Mydriatic (tropicamide phenylephrine 1.0%) — 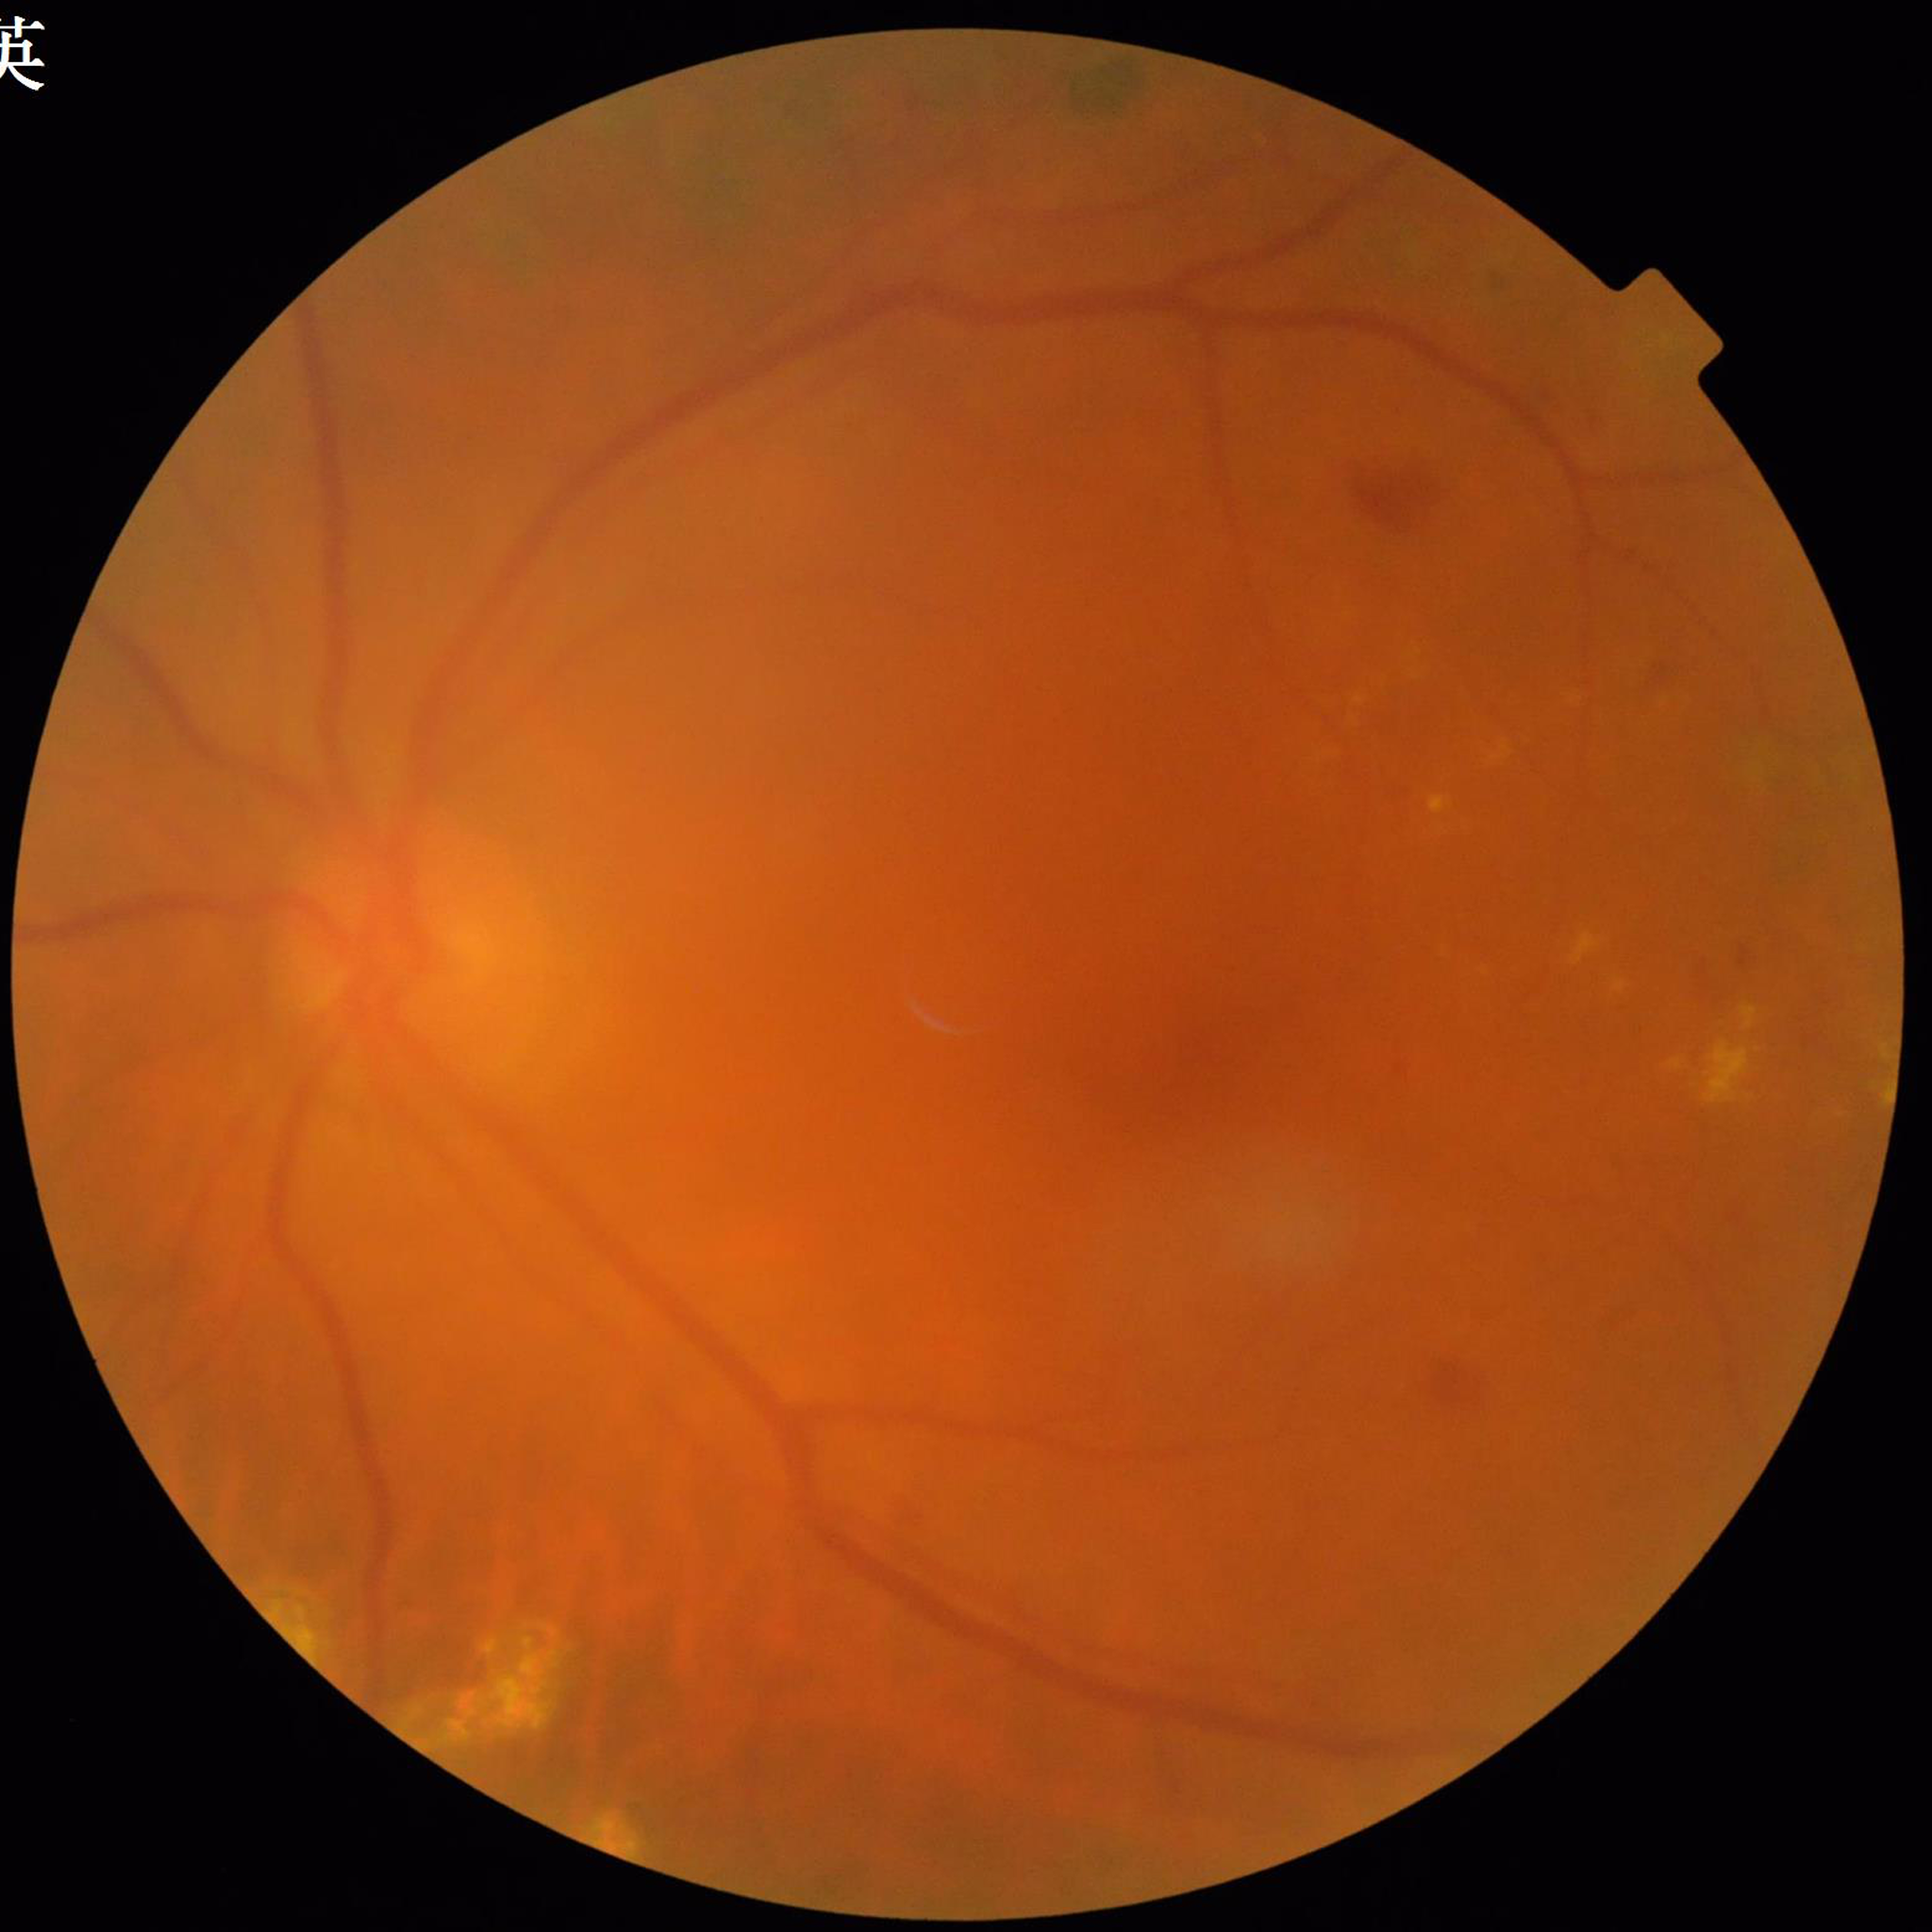 Diagnosis: diabetic retinopathy
Image quality: suboptimal — blur